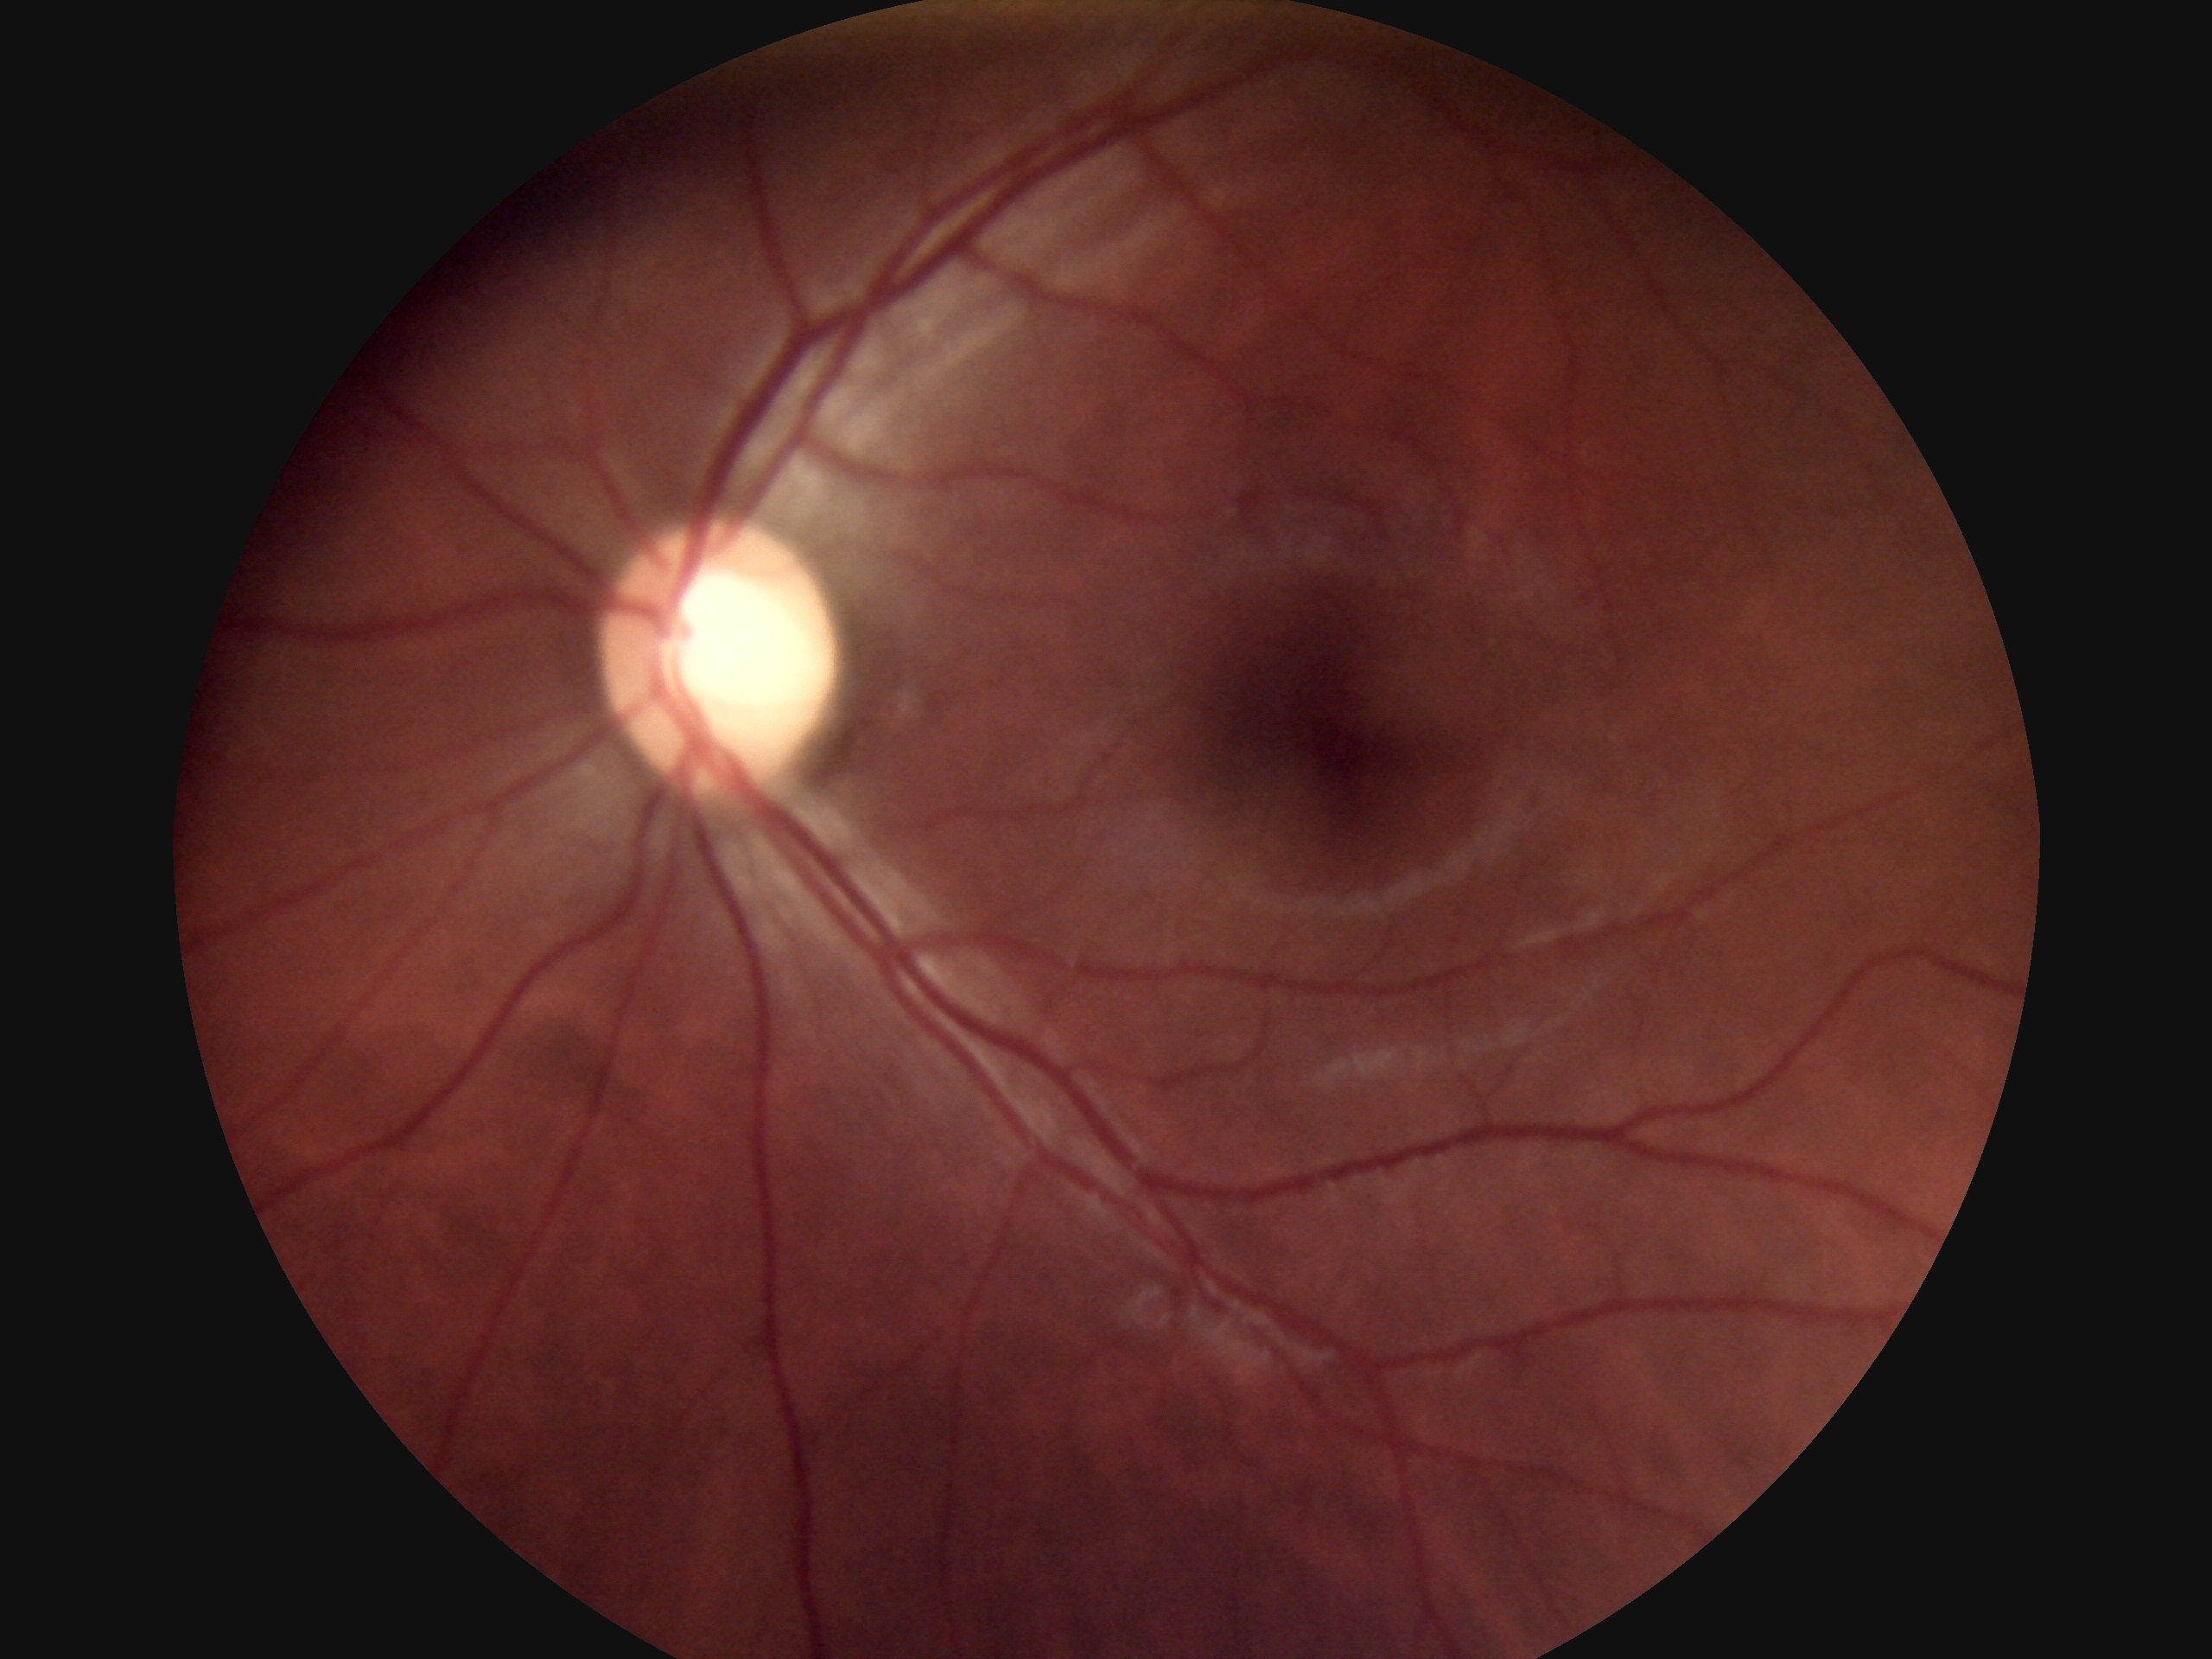

DR is grade 0 (no apparent retinopathy).